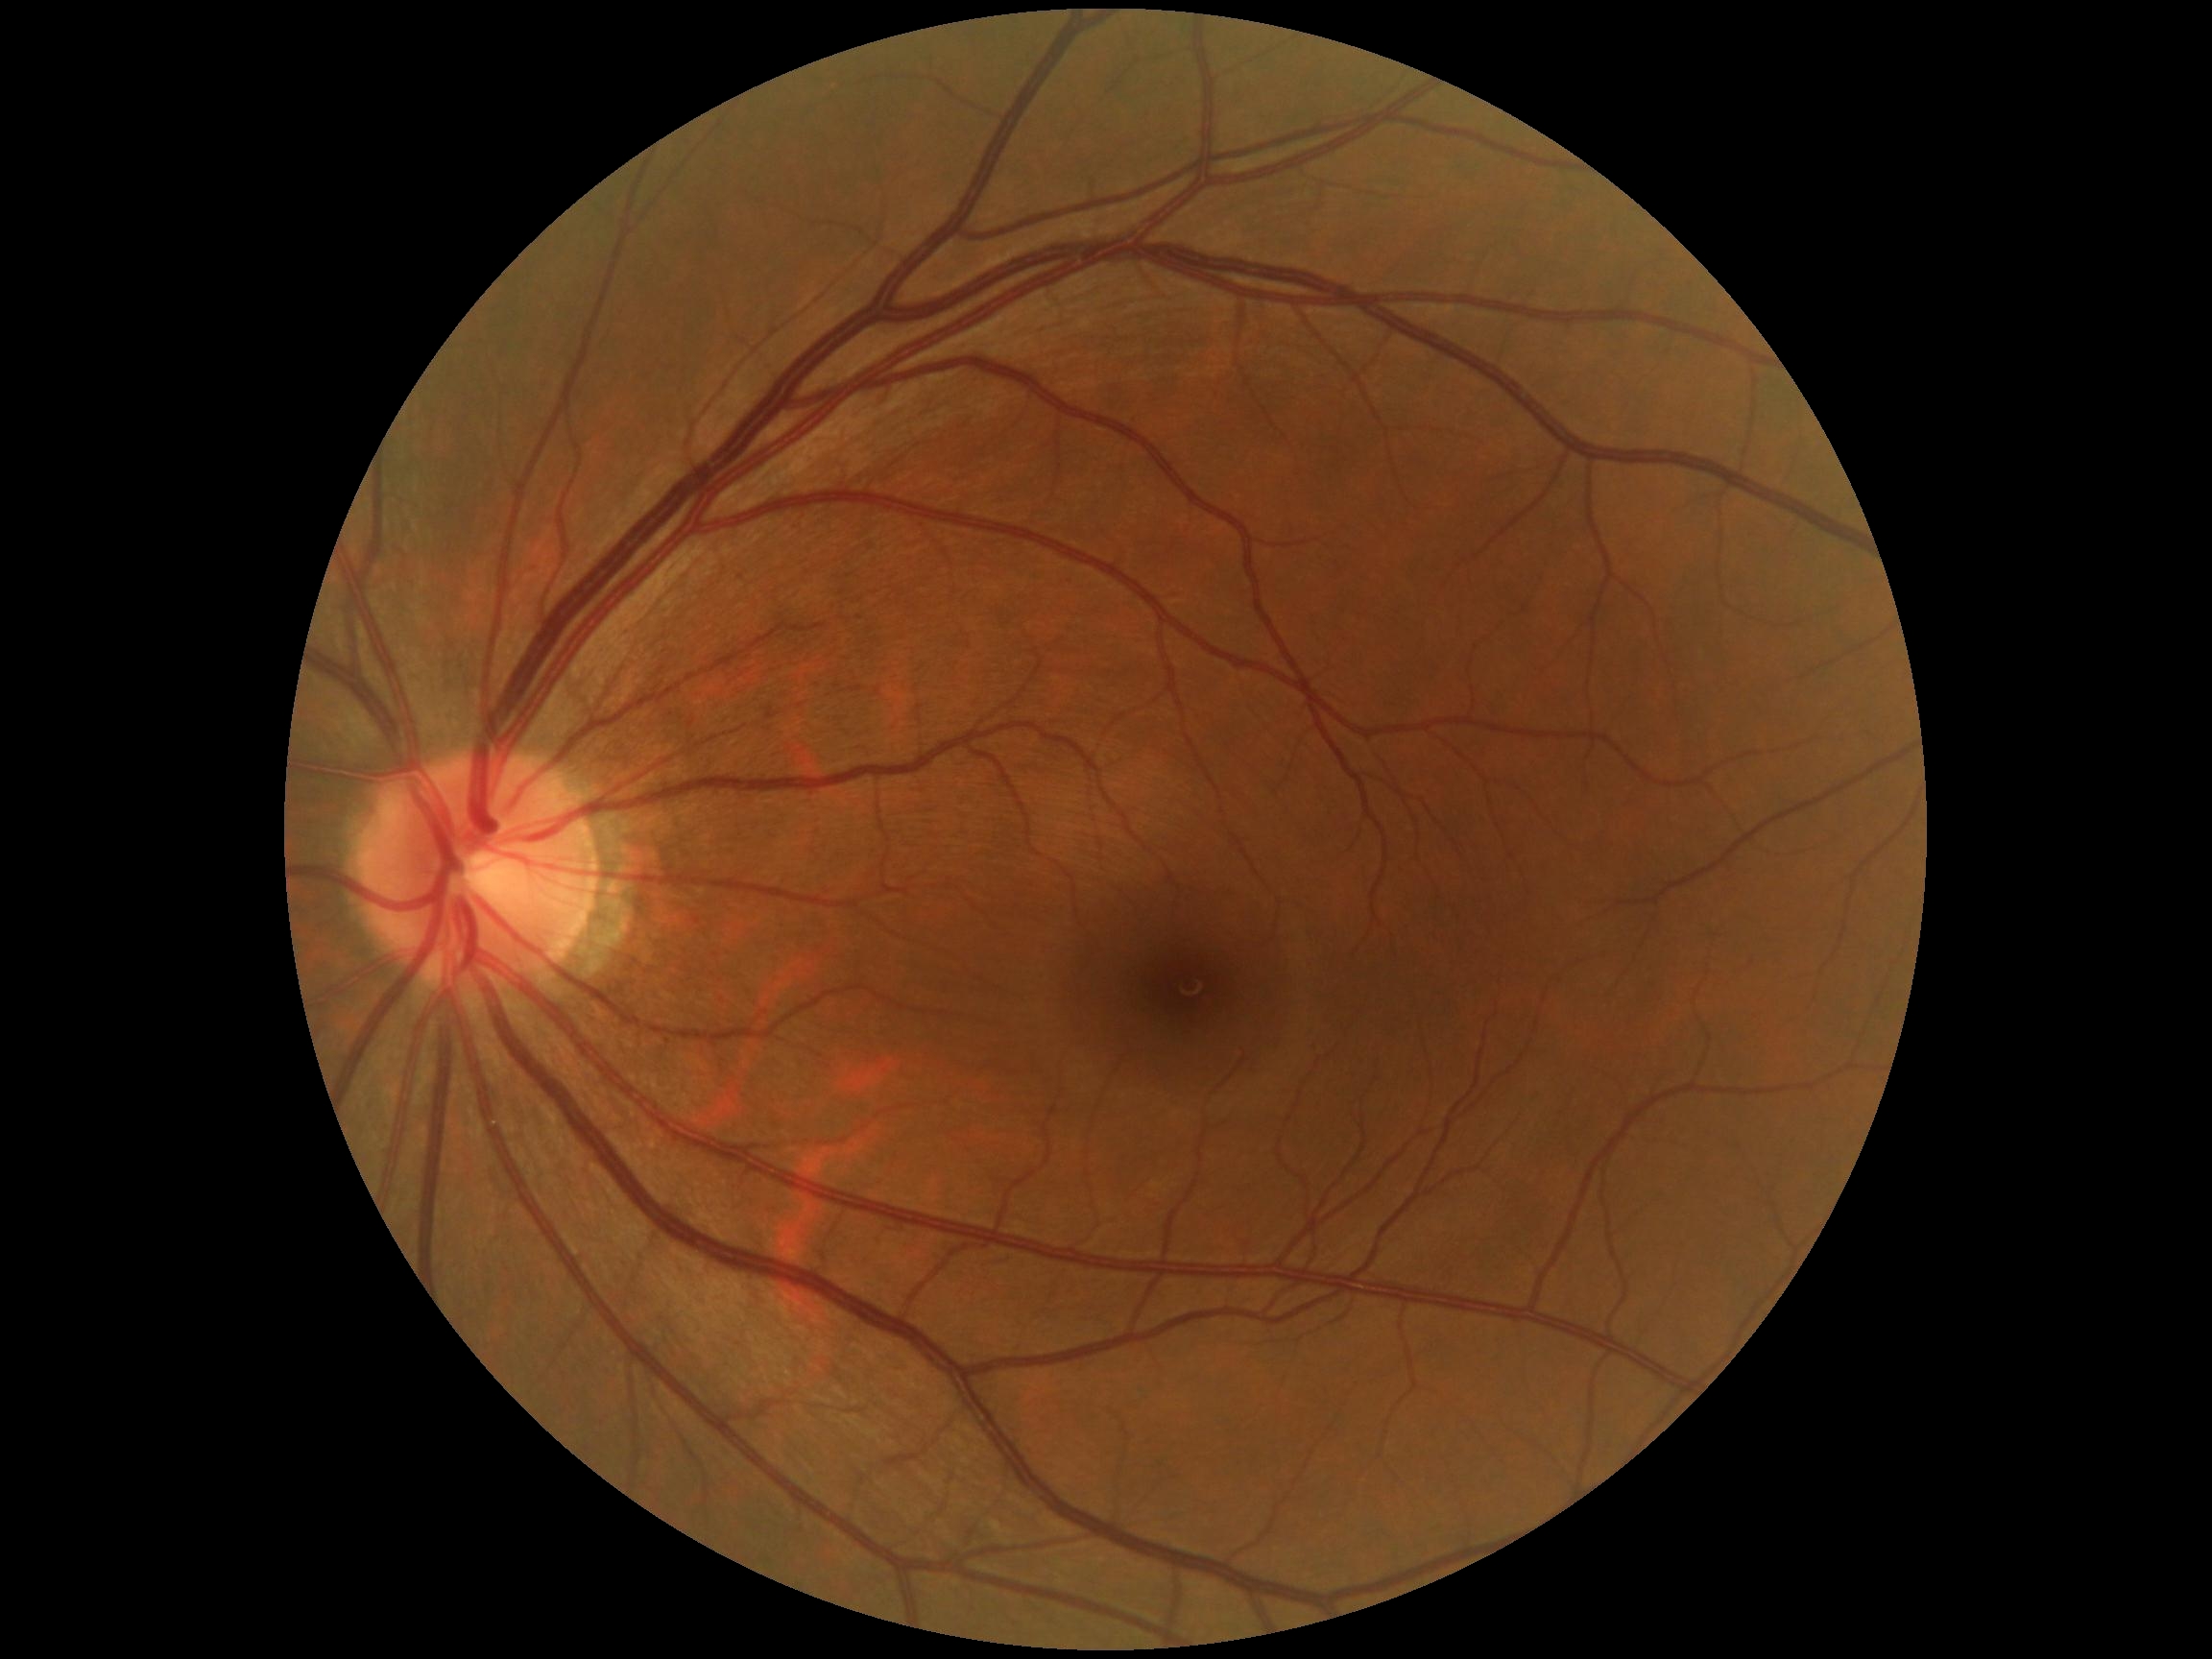 Retinopathy is 0/4.